Color fundus photograph; 45-degree field of view; 2212 x 1659 pixels
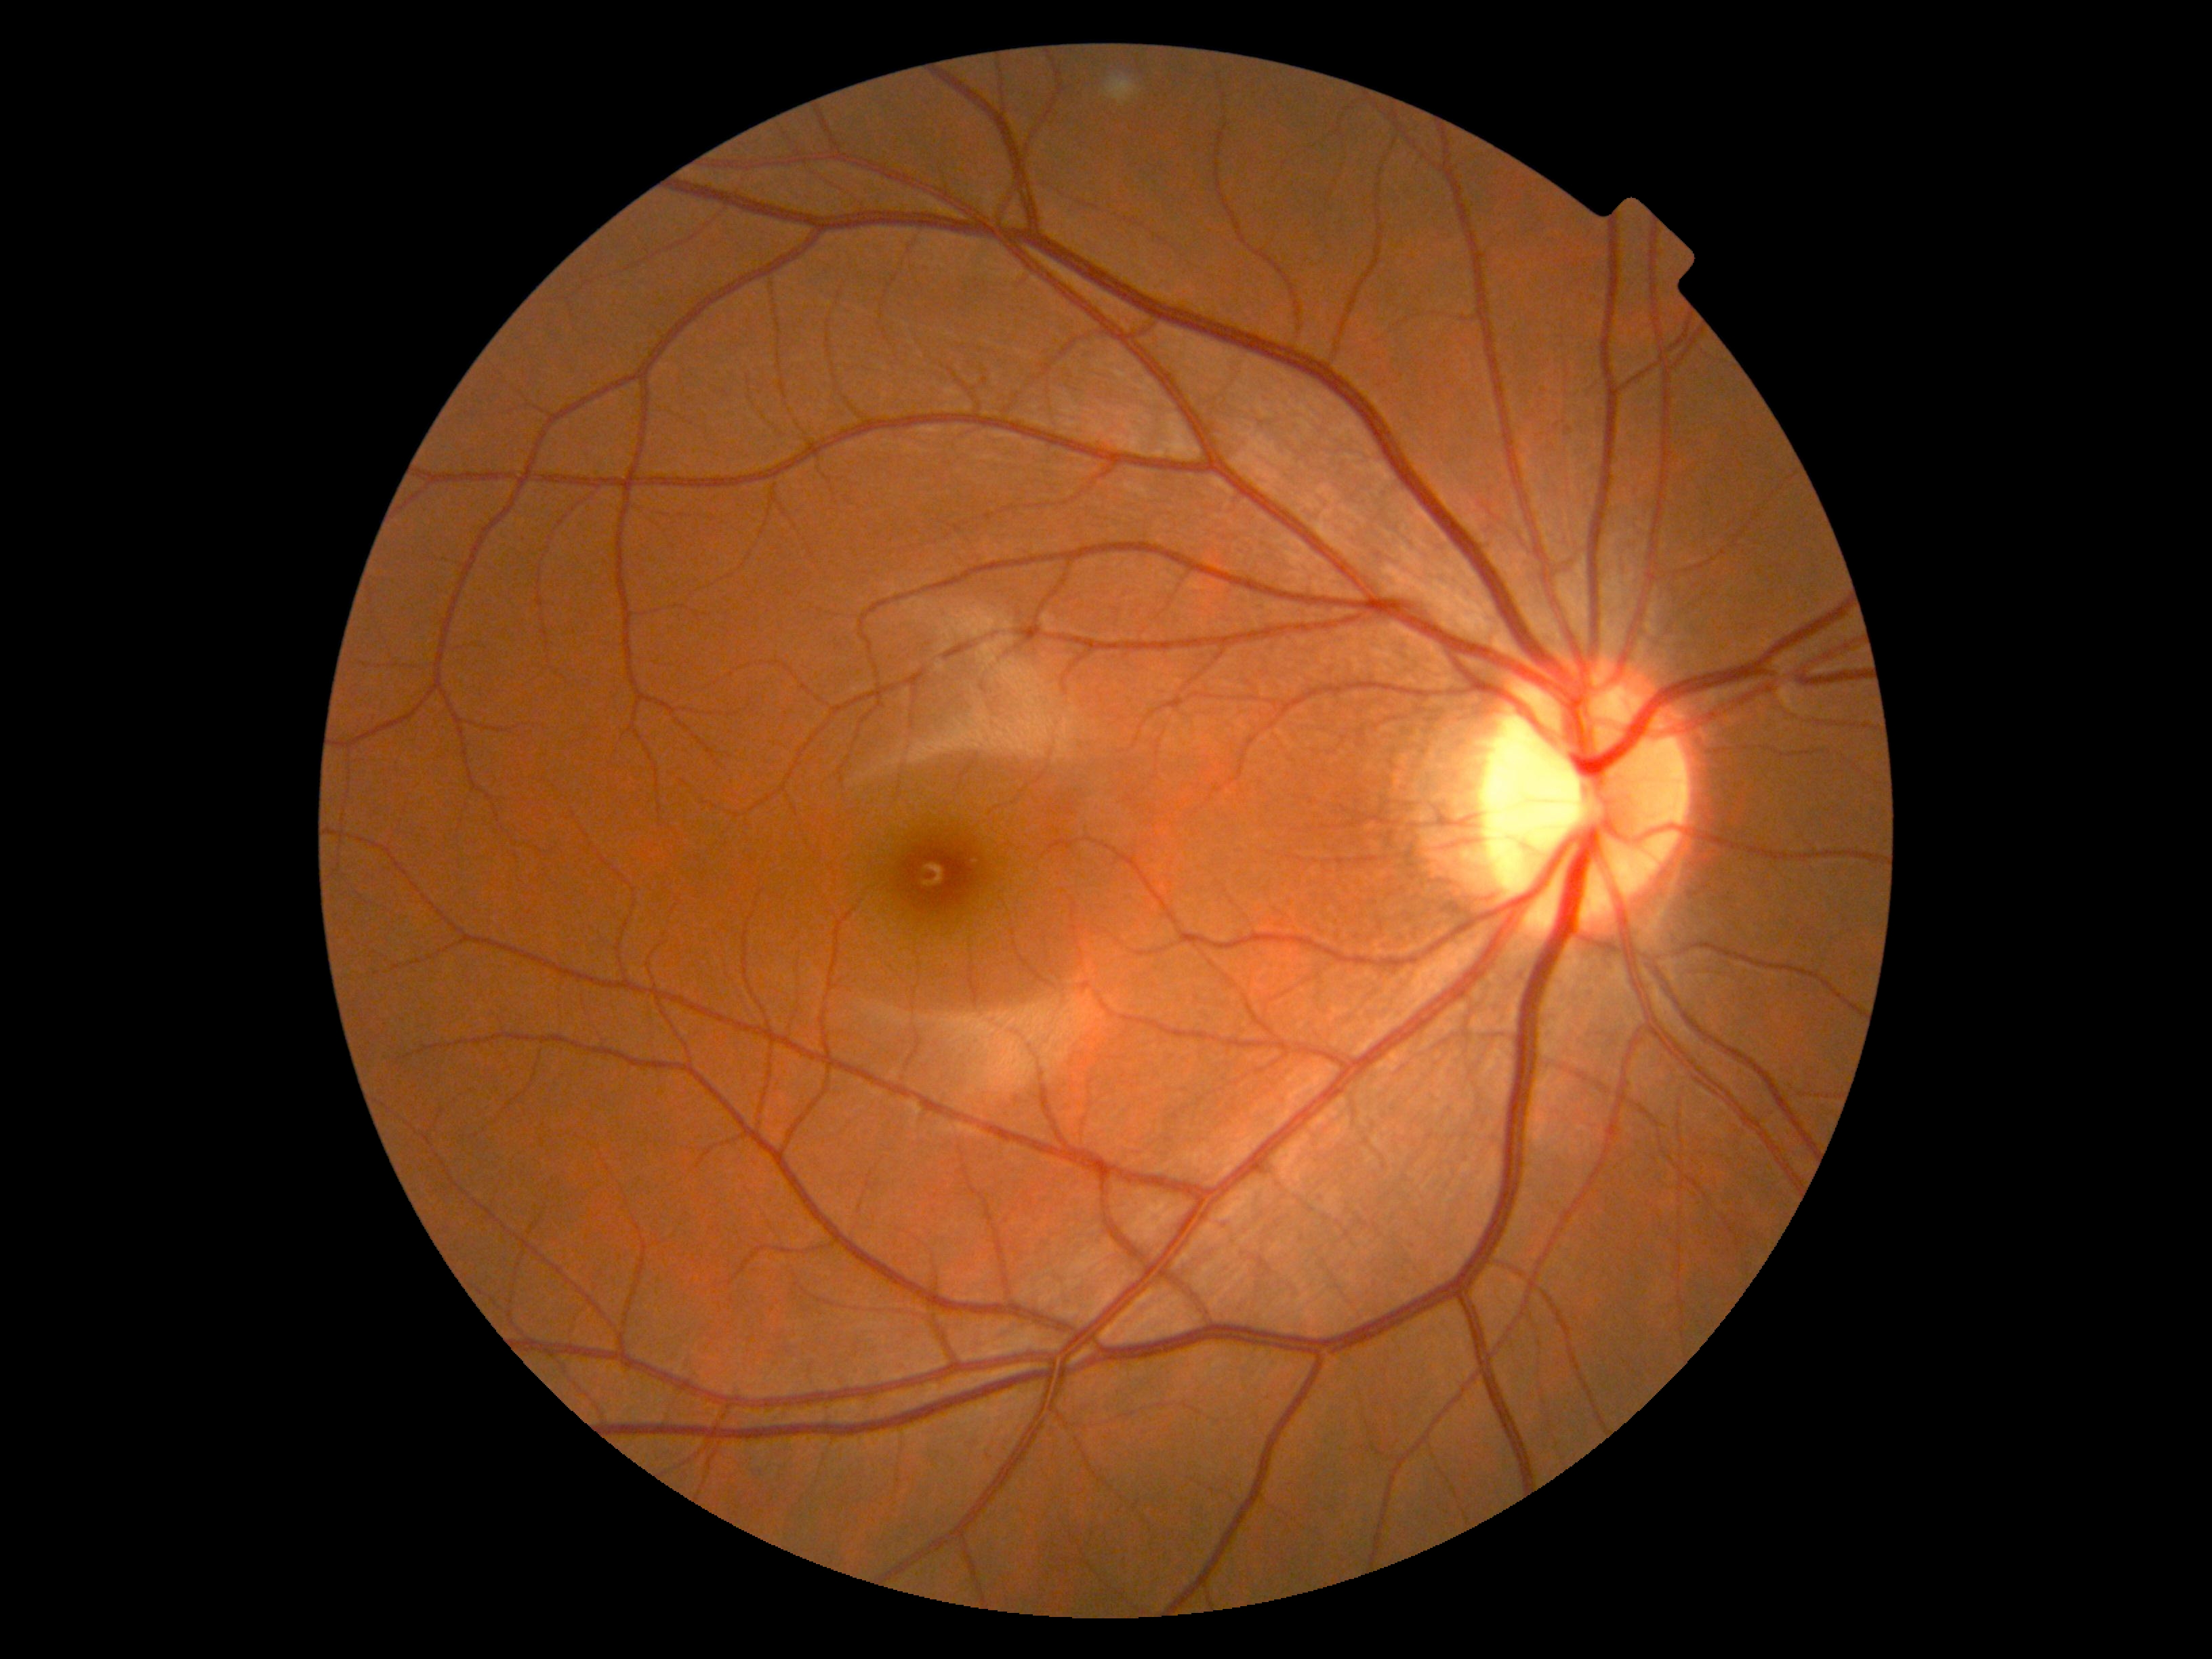

No signs of diabetic retinopathy. DR stage: grade 0 (no apparent retinopathy).